Posterior pole color fundus photograph: 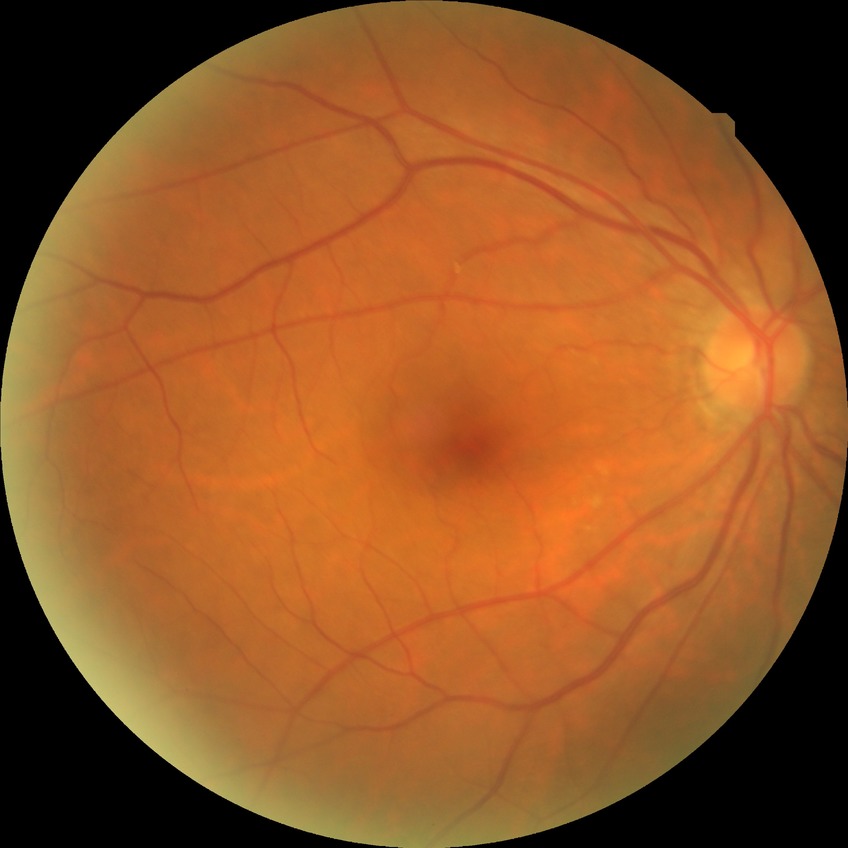 Diabetic retinopathy grade is no diabetic retinopathy.